1470x1137. Color fundus image. 45-degree field of view — 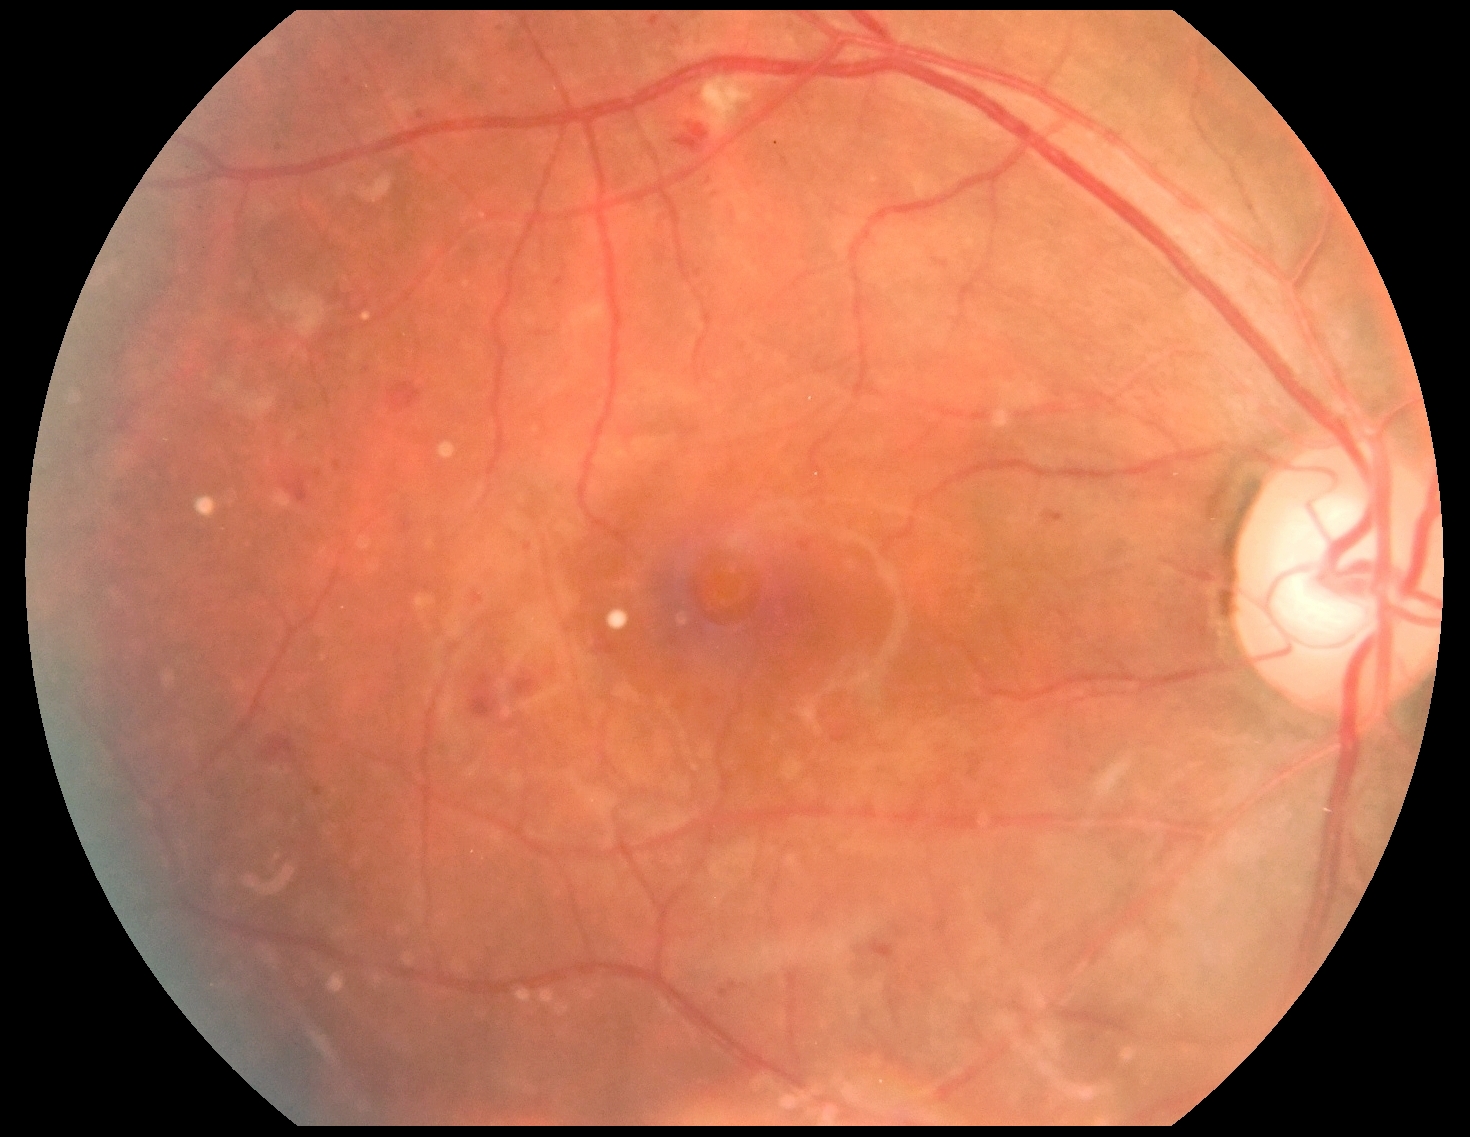
Retinopathy is moderate non-proliferative diabetic retinopathy (grade 2).